512 by 512 pixels. Retinal fundus photograph: 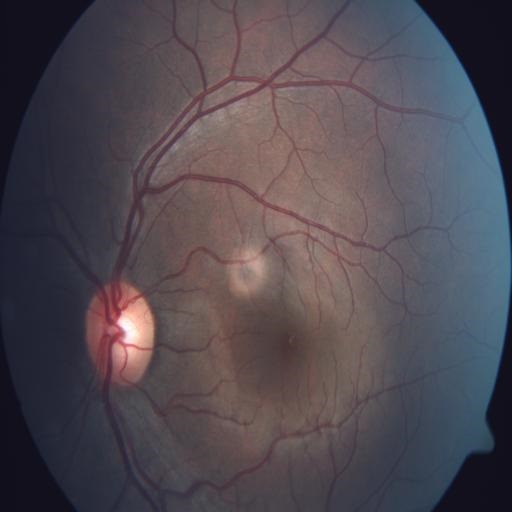

The fundus appears normal with no pathological findings.